Fundus photo
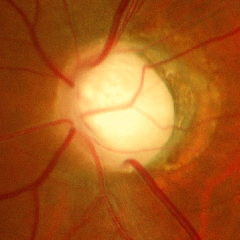
Advanced-stage glaucoma.